Fundus photo.
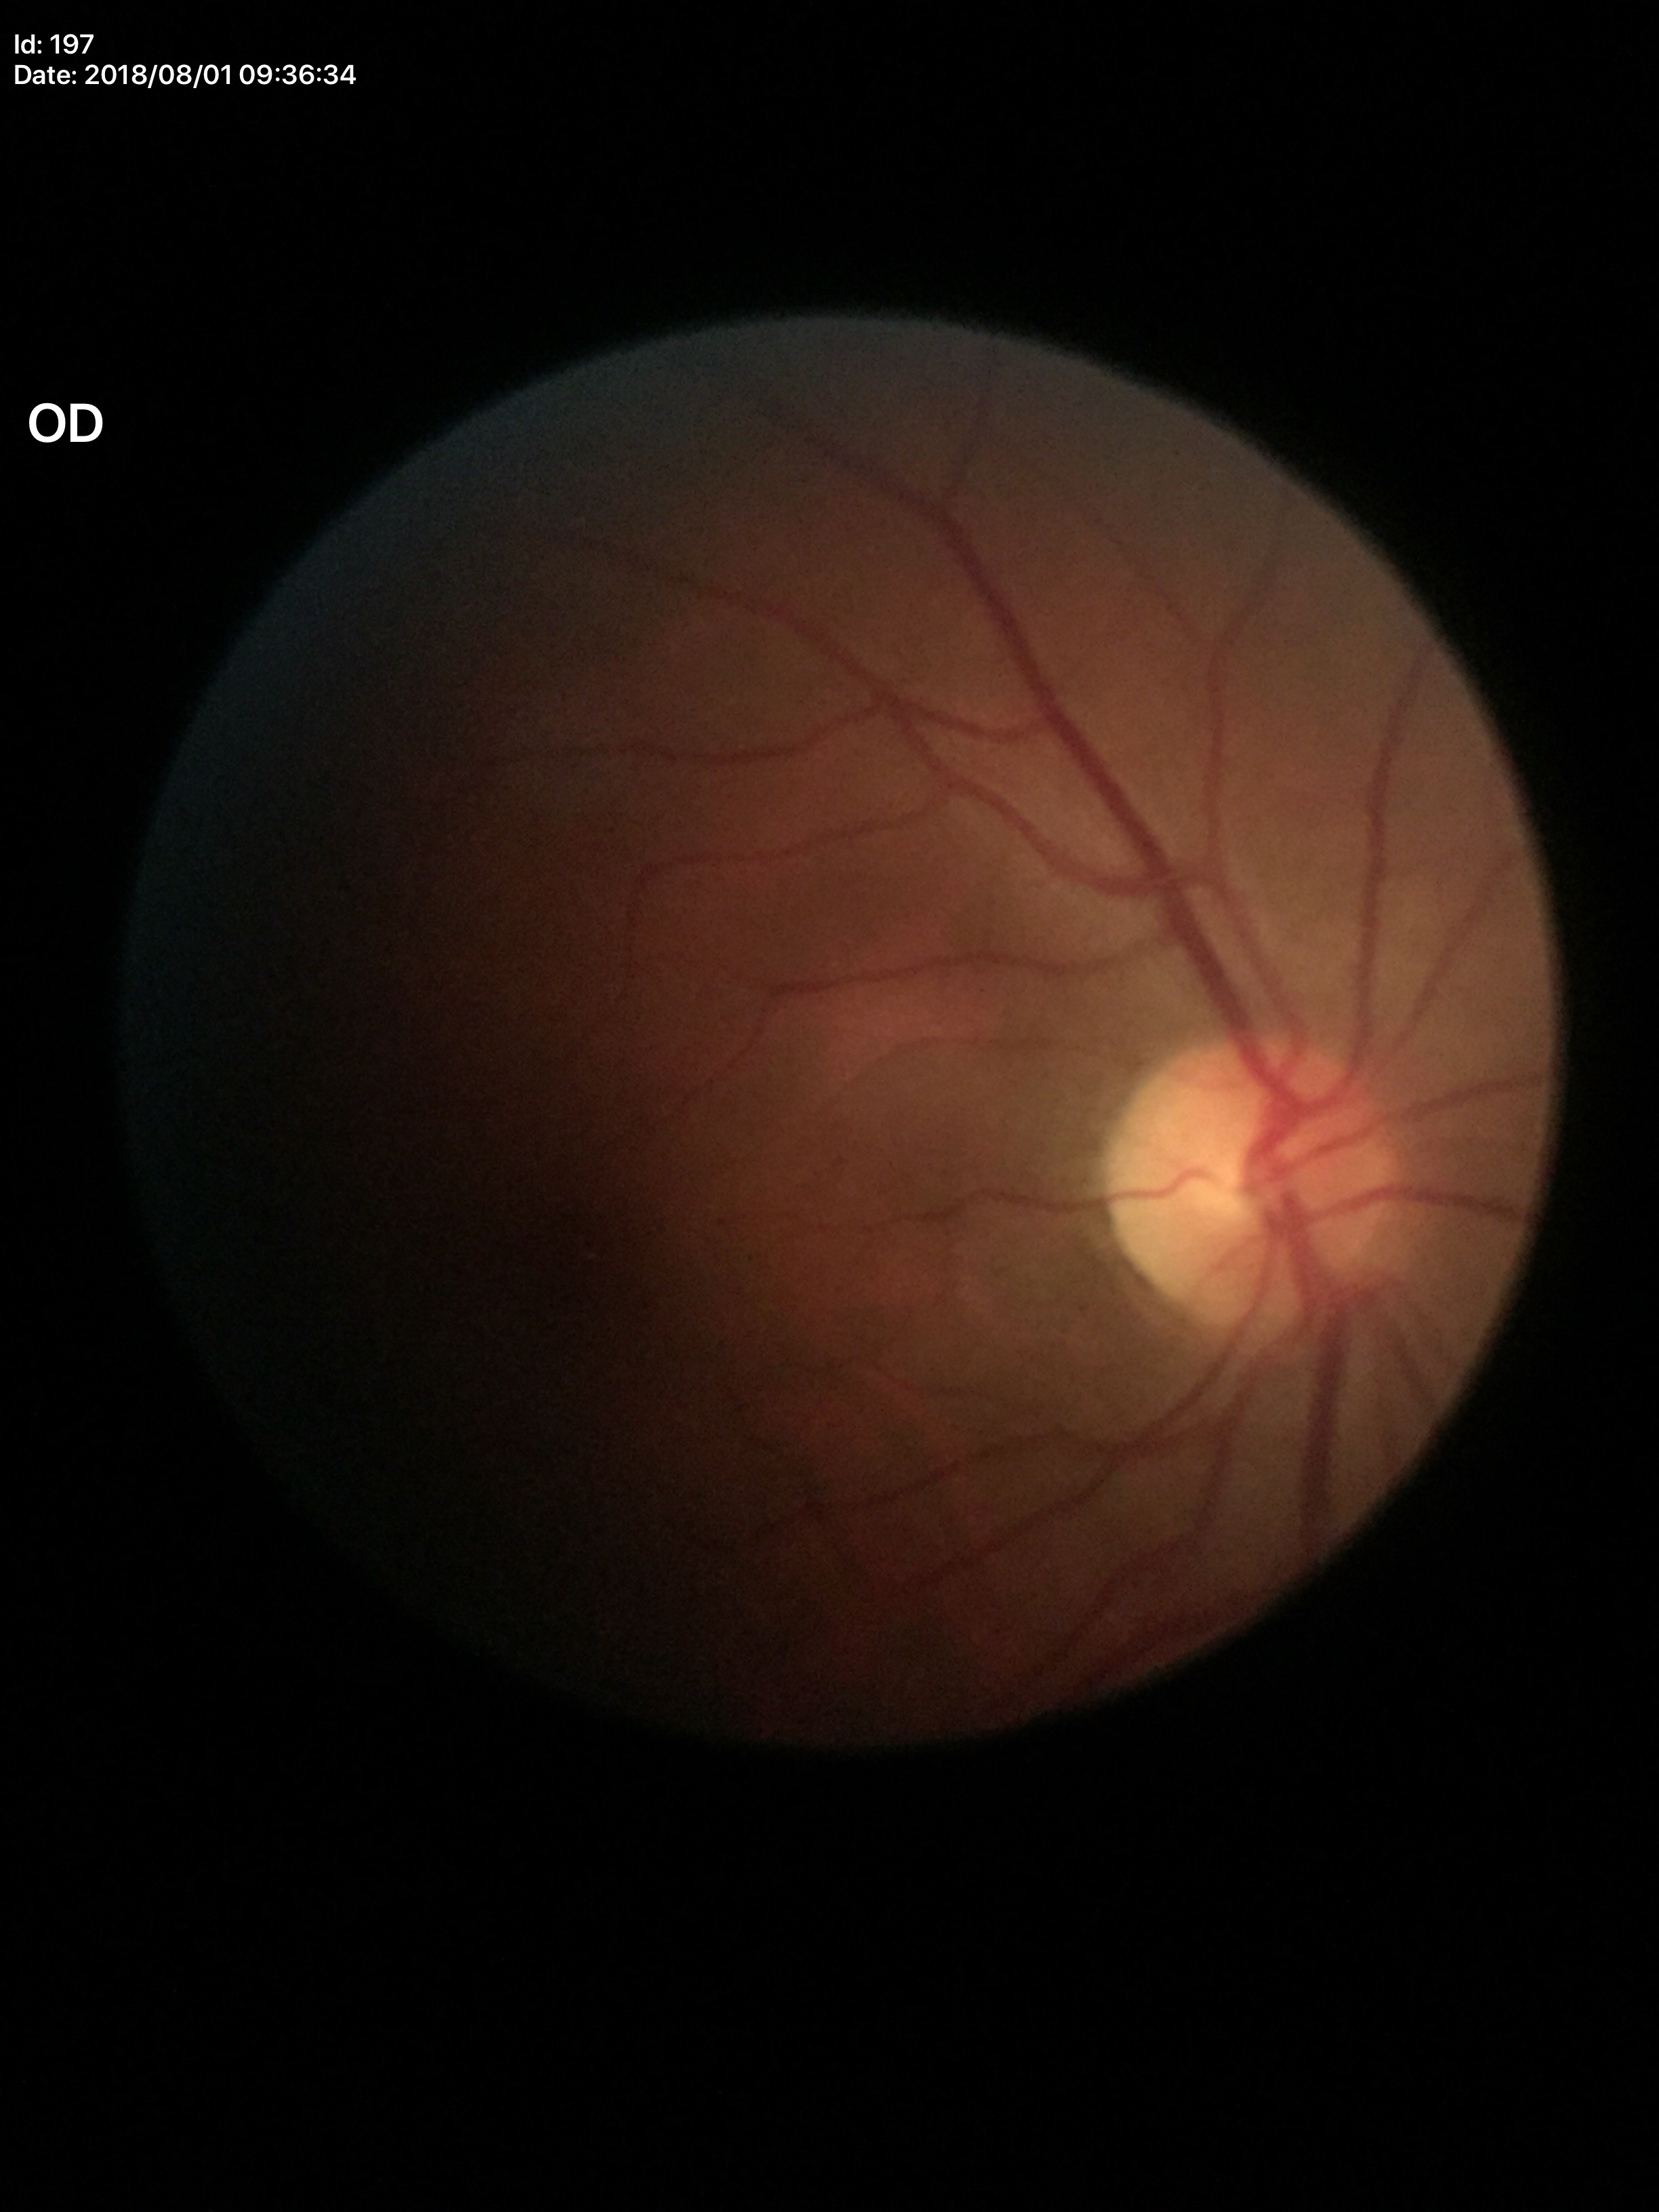 Q: What is the vertical cup-to-disc ratio?
A: 0.46
Q: Is there glaucoma suspicion?
A: not suspect